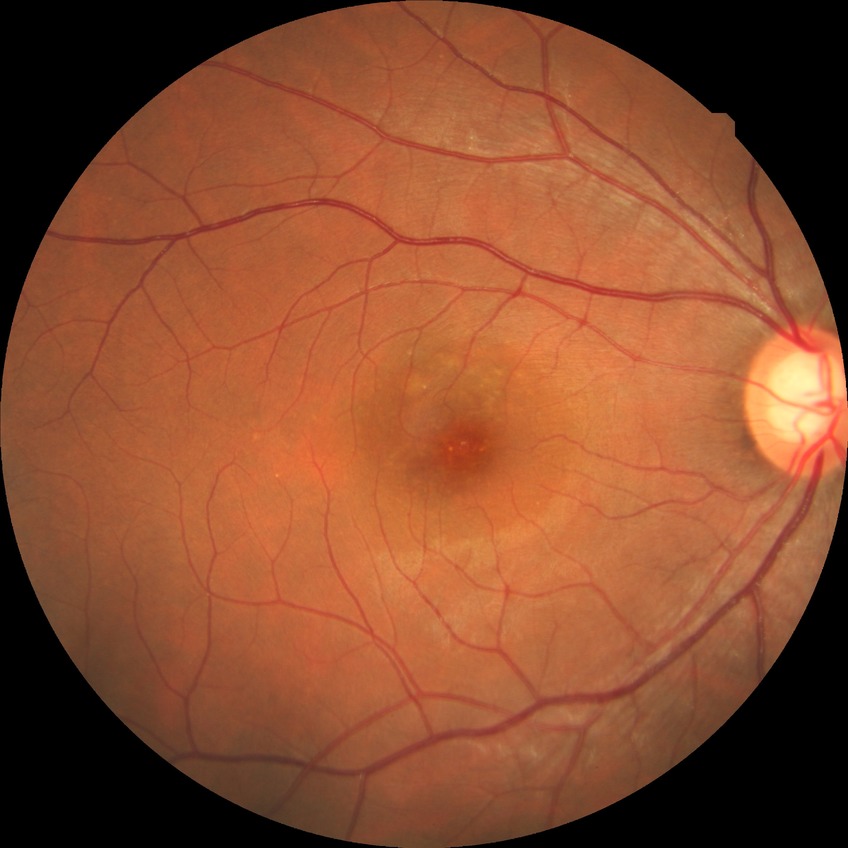
Diabetic retinopathy (DR) is no diabetic retinopathy (NDR).